Tabletop color fundus camera image
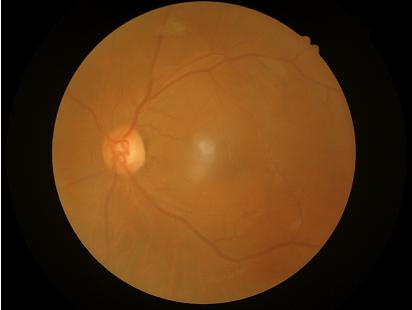

Image quality is suboptimal.
Reduced sharpness with visible blur.
No over- or under-exposure.
Contrast is low.